CFP. 45° FOV: 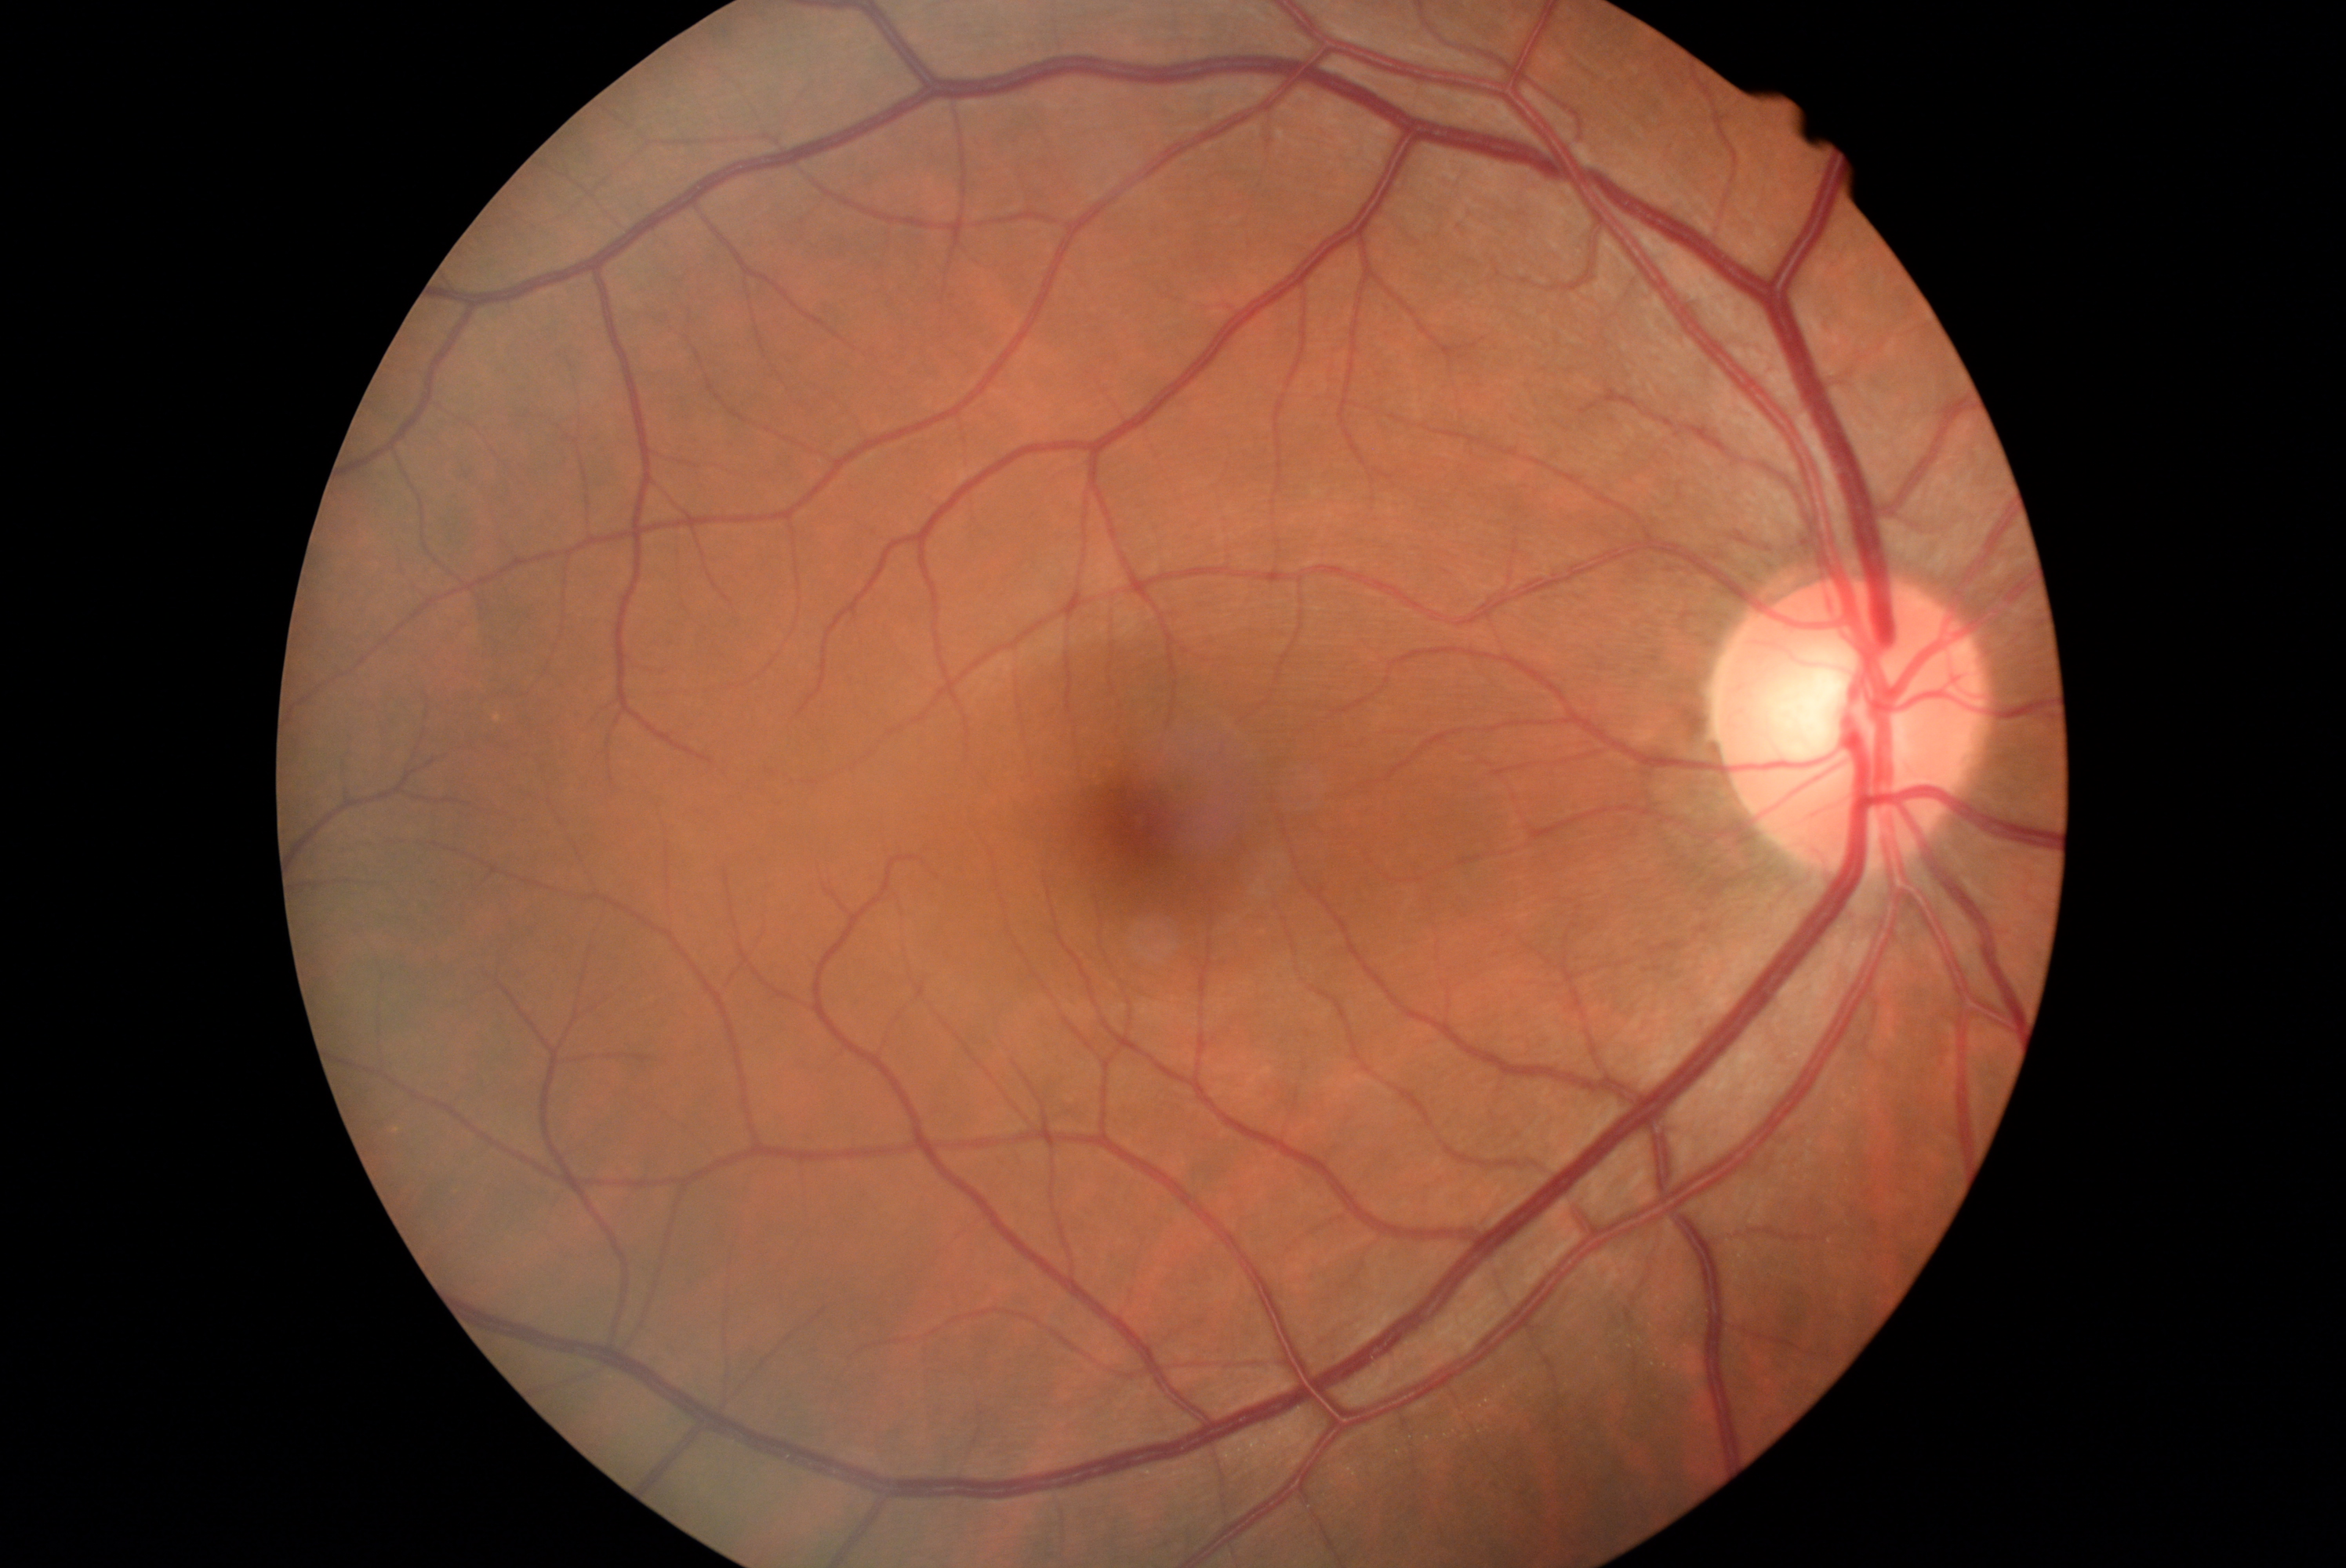 Diabetic retinopathy (DR) is 0/4.